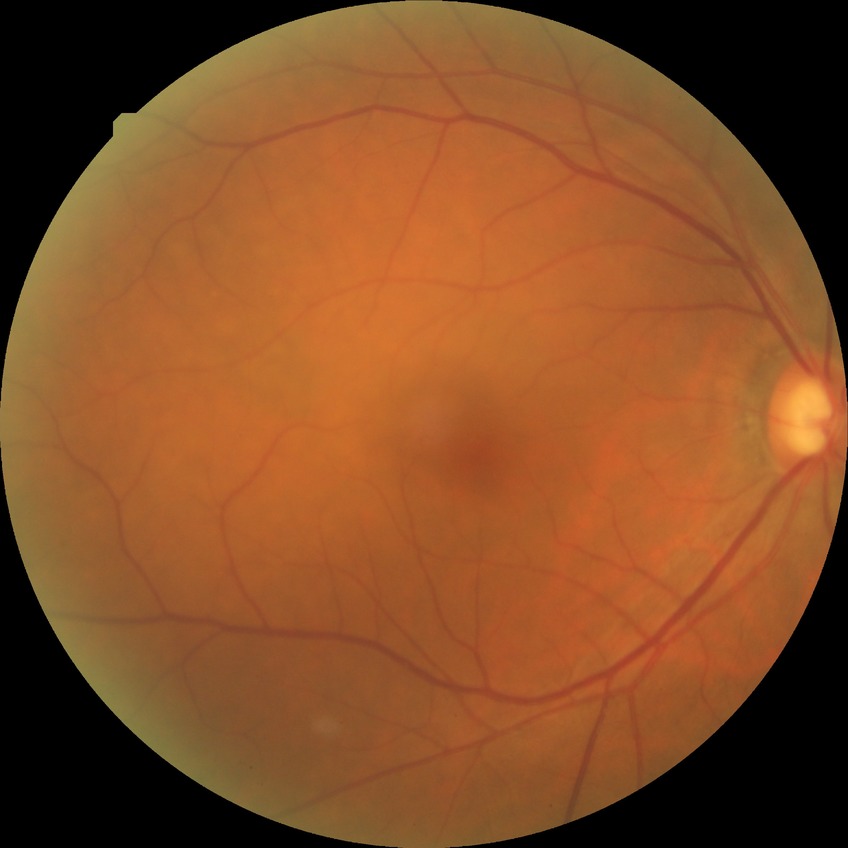

Diabetic retinopathy grade: no diabetic retinopathy.